Ultra-widefield fundus mosaic; 200° field of view.
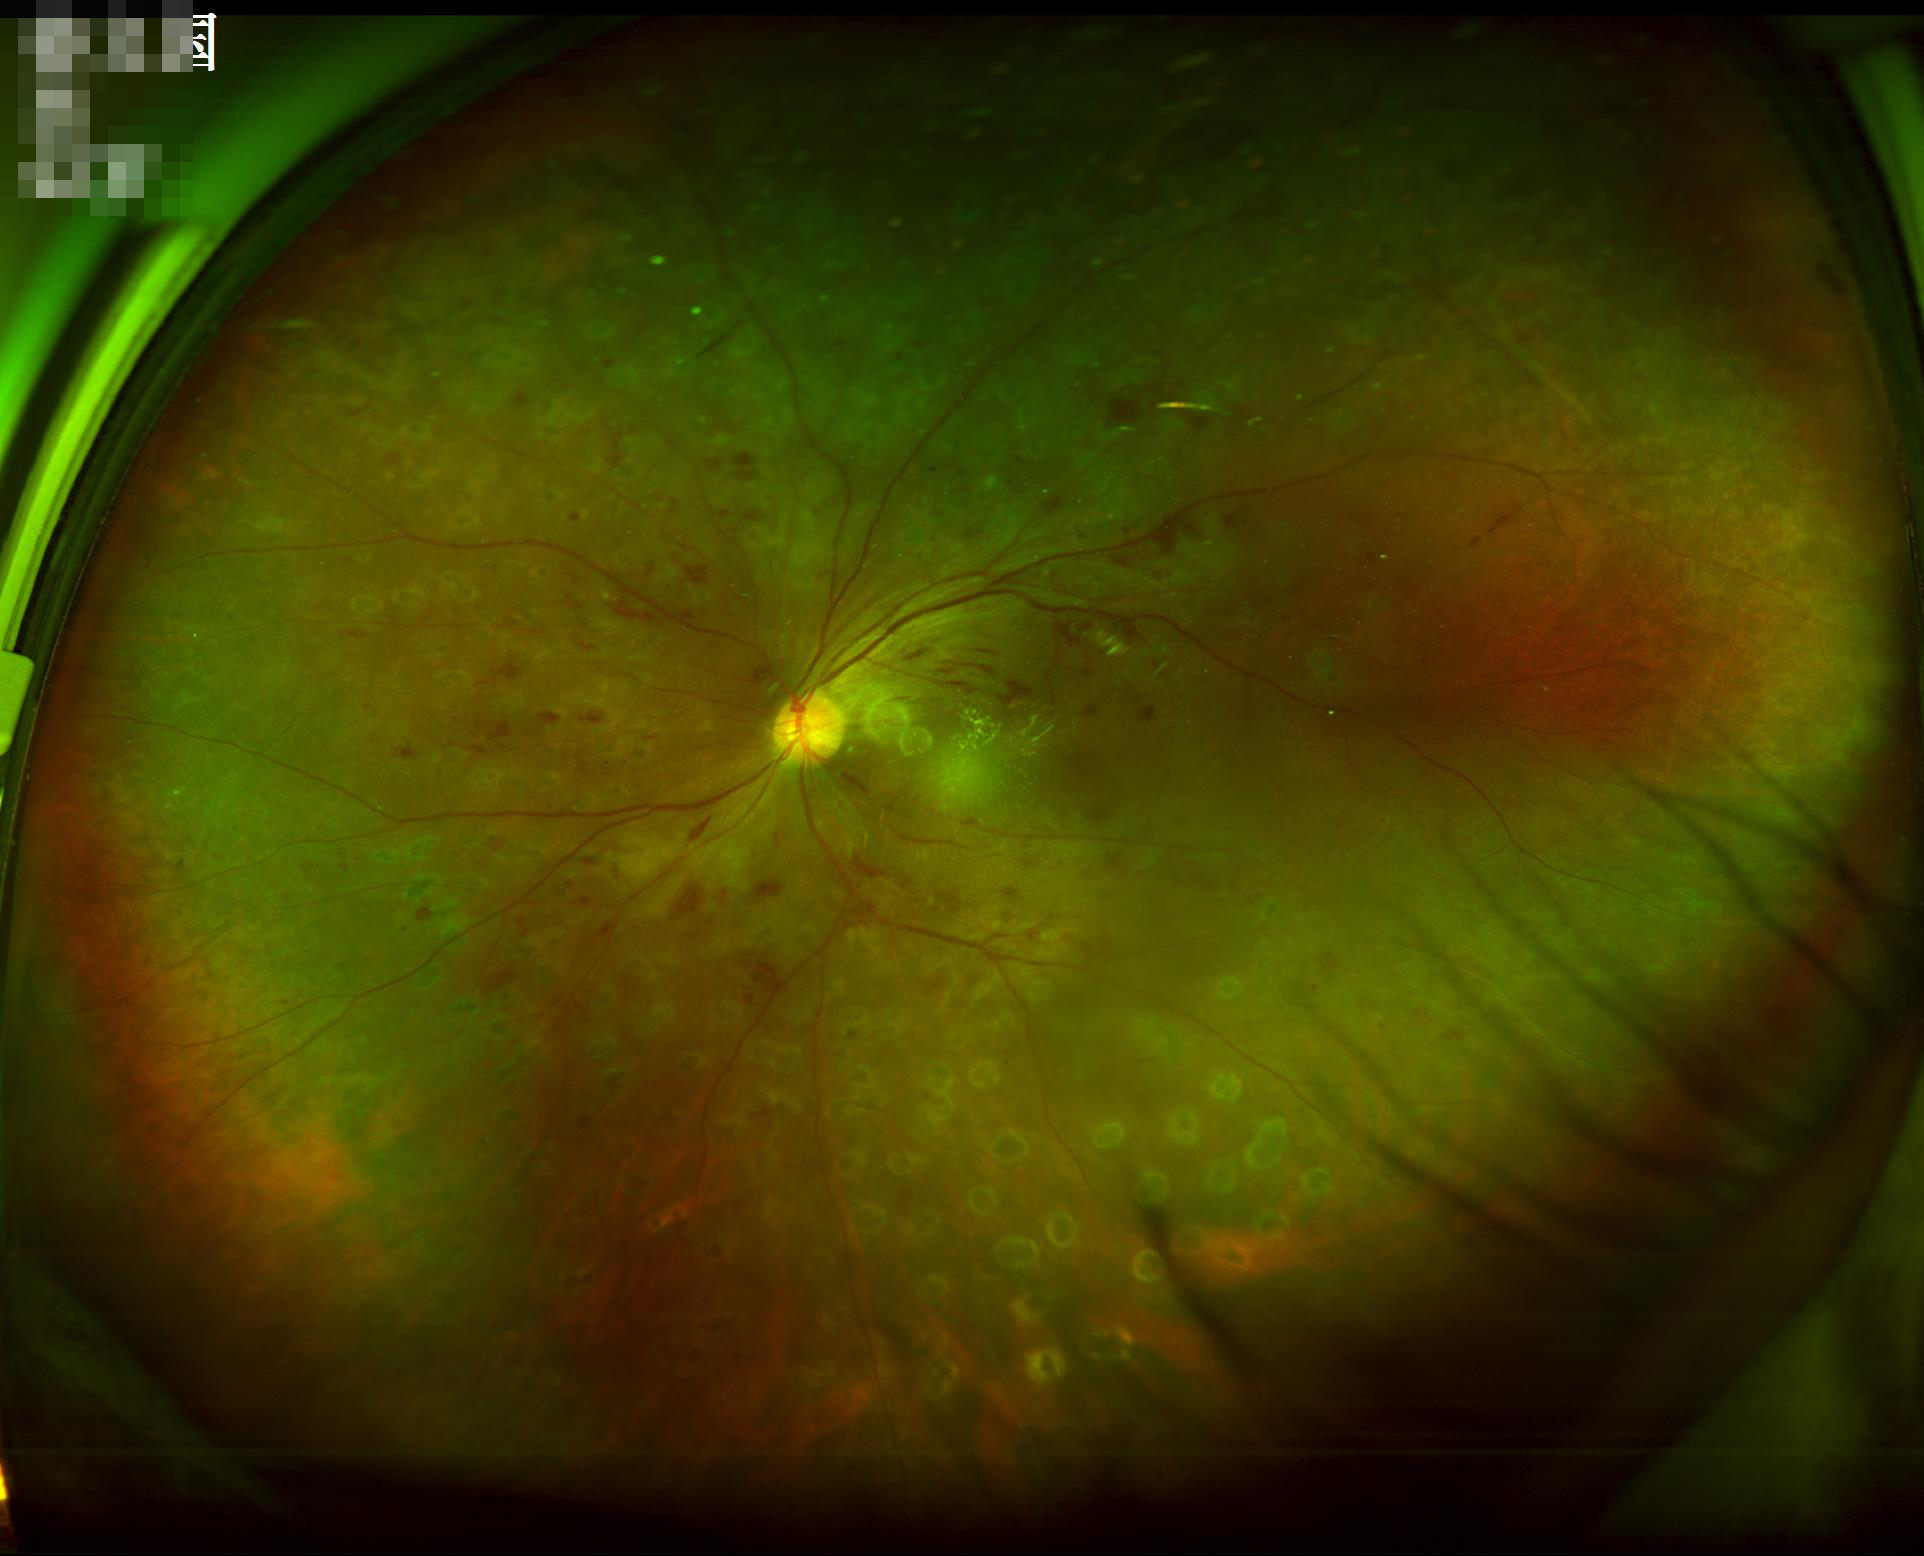

Image quality:
- overall: satisfactory
- focus: sharp